2352 by 1568 pixels. 45° FOV. Color fundus image.
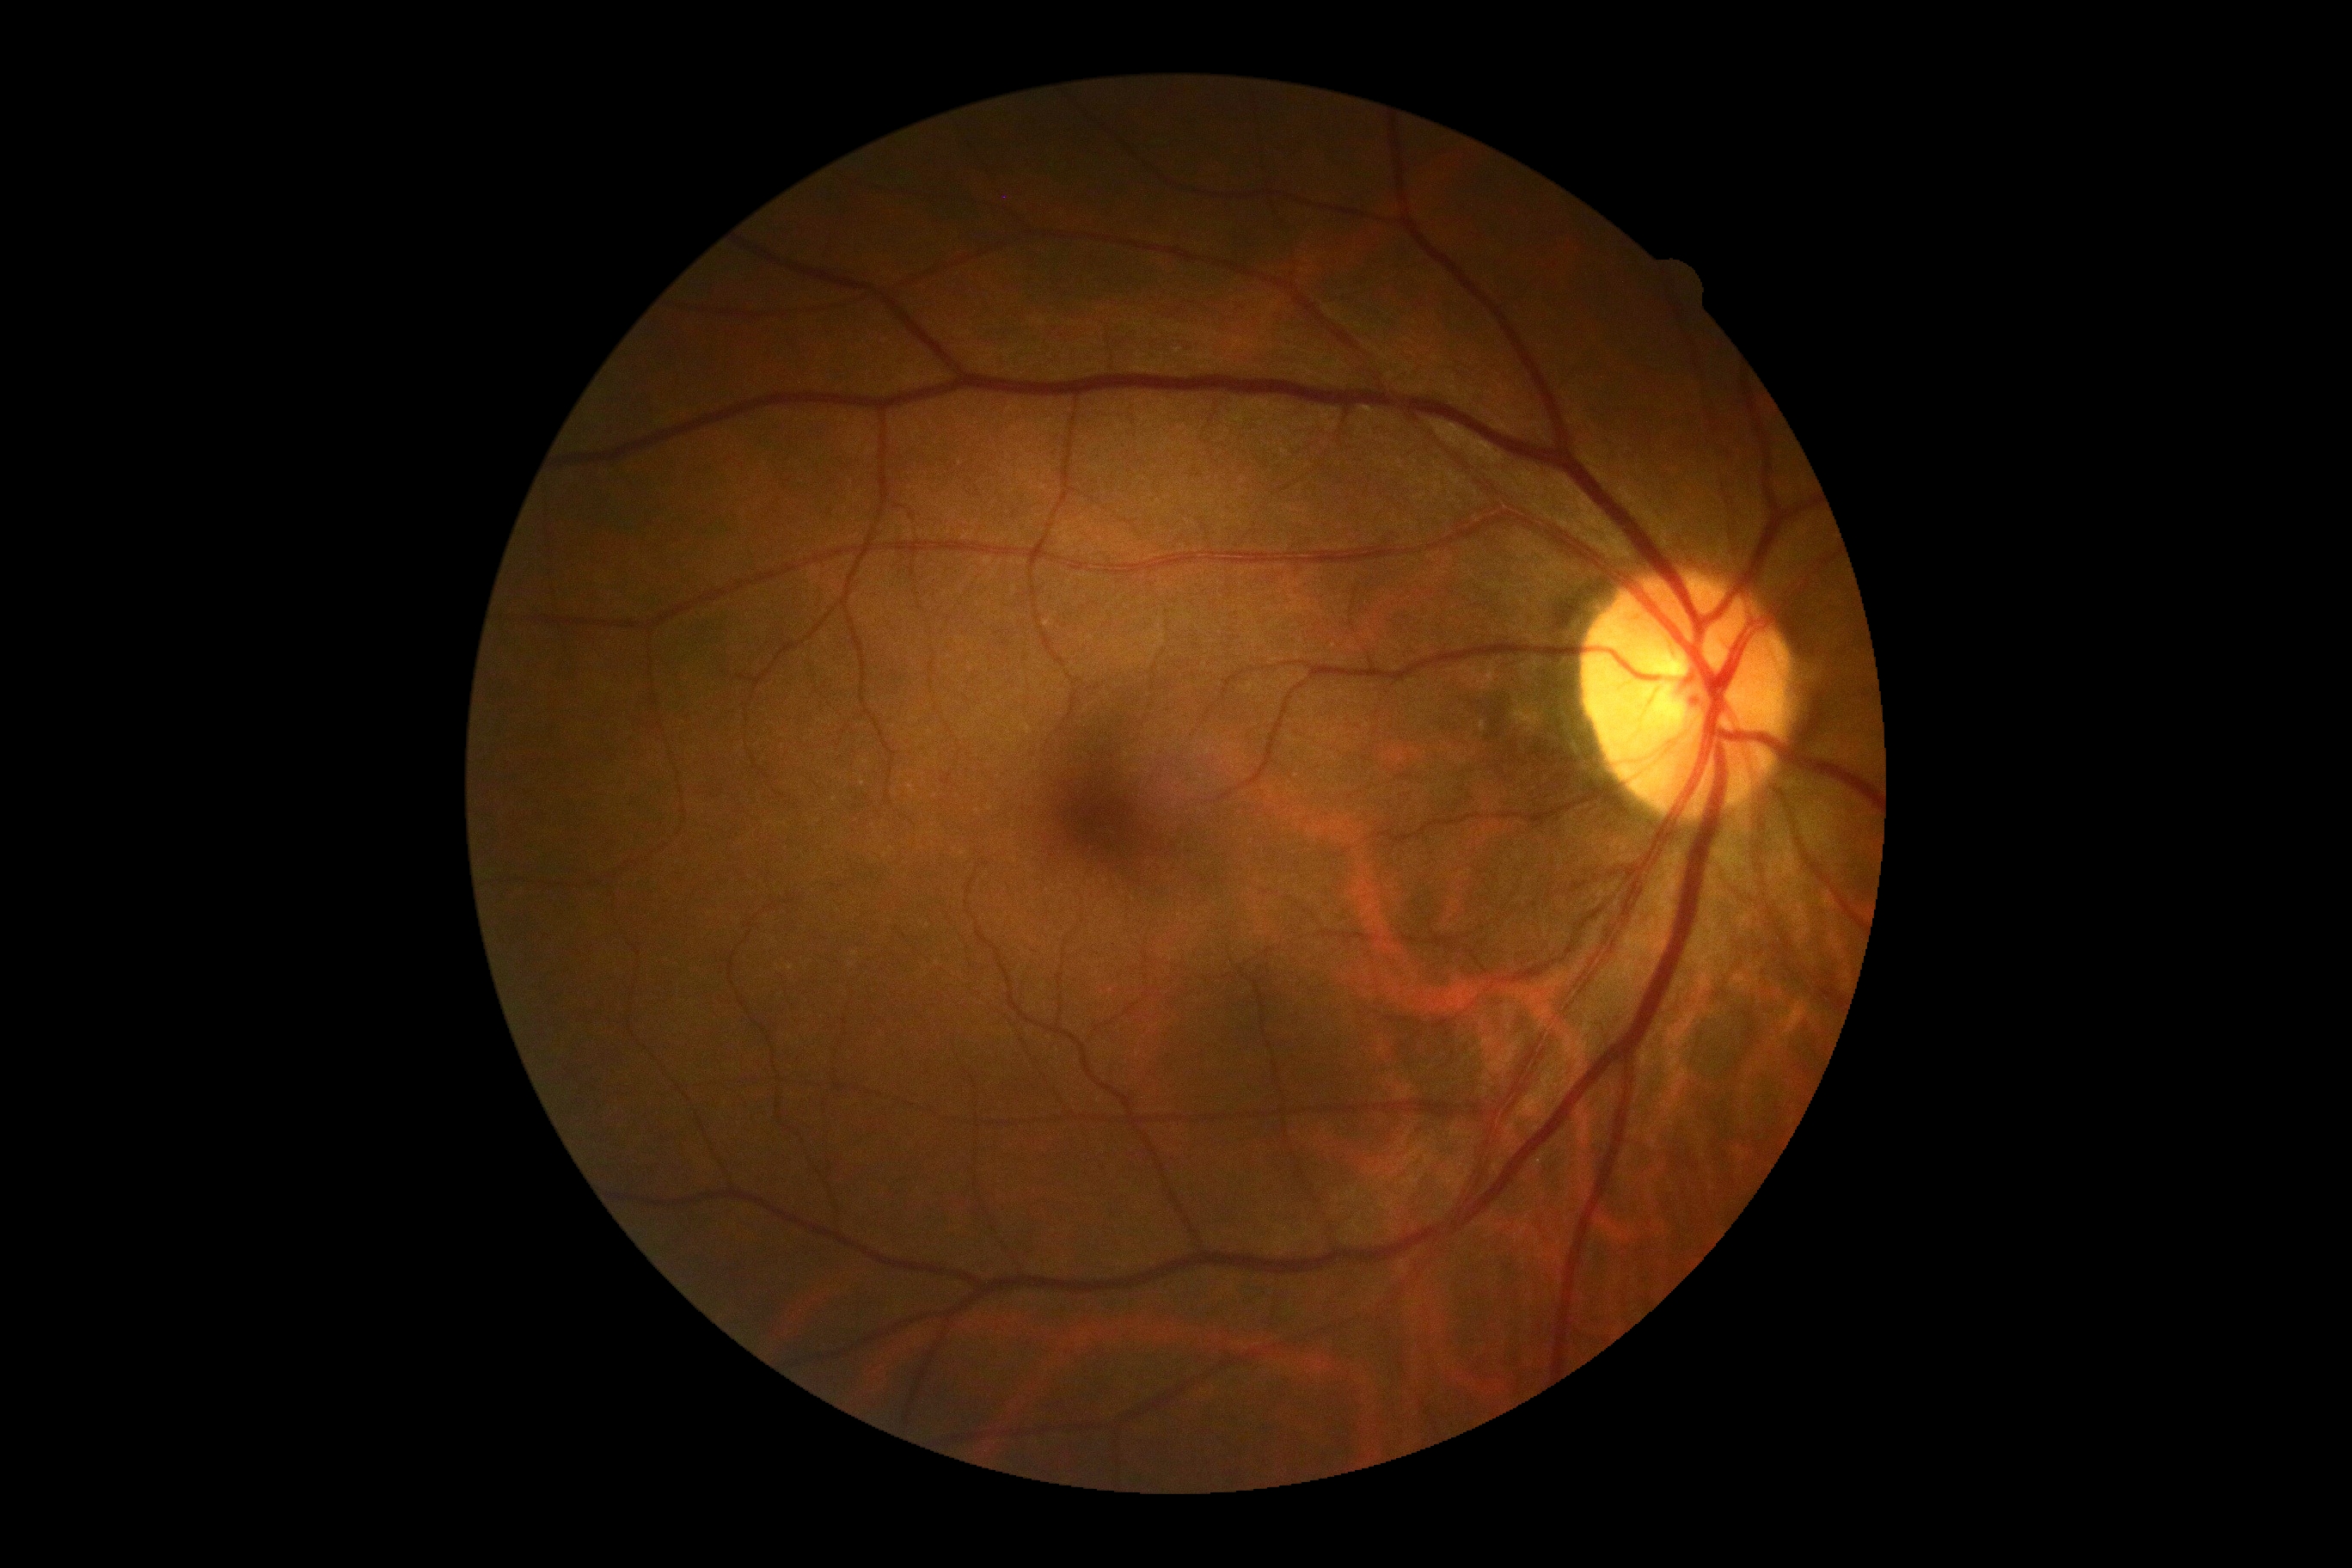
DR grade = 0 (no apparent retinopathy).